2048 by 1536 pixels, 45° FOV, color fundus image — 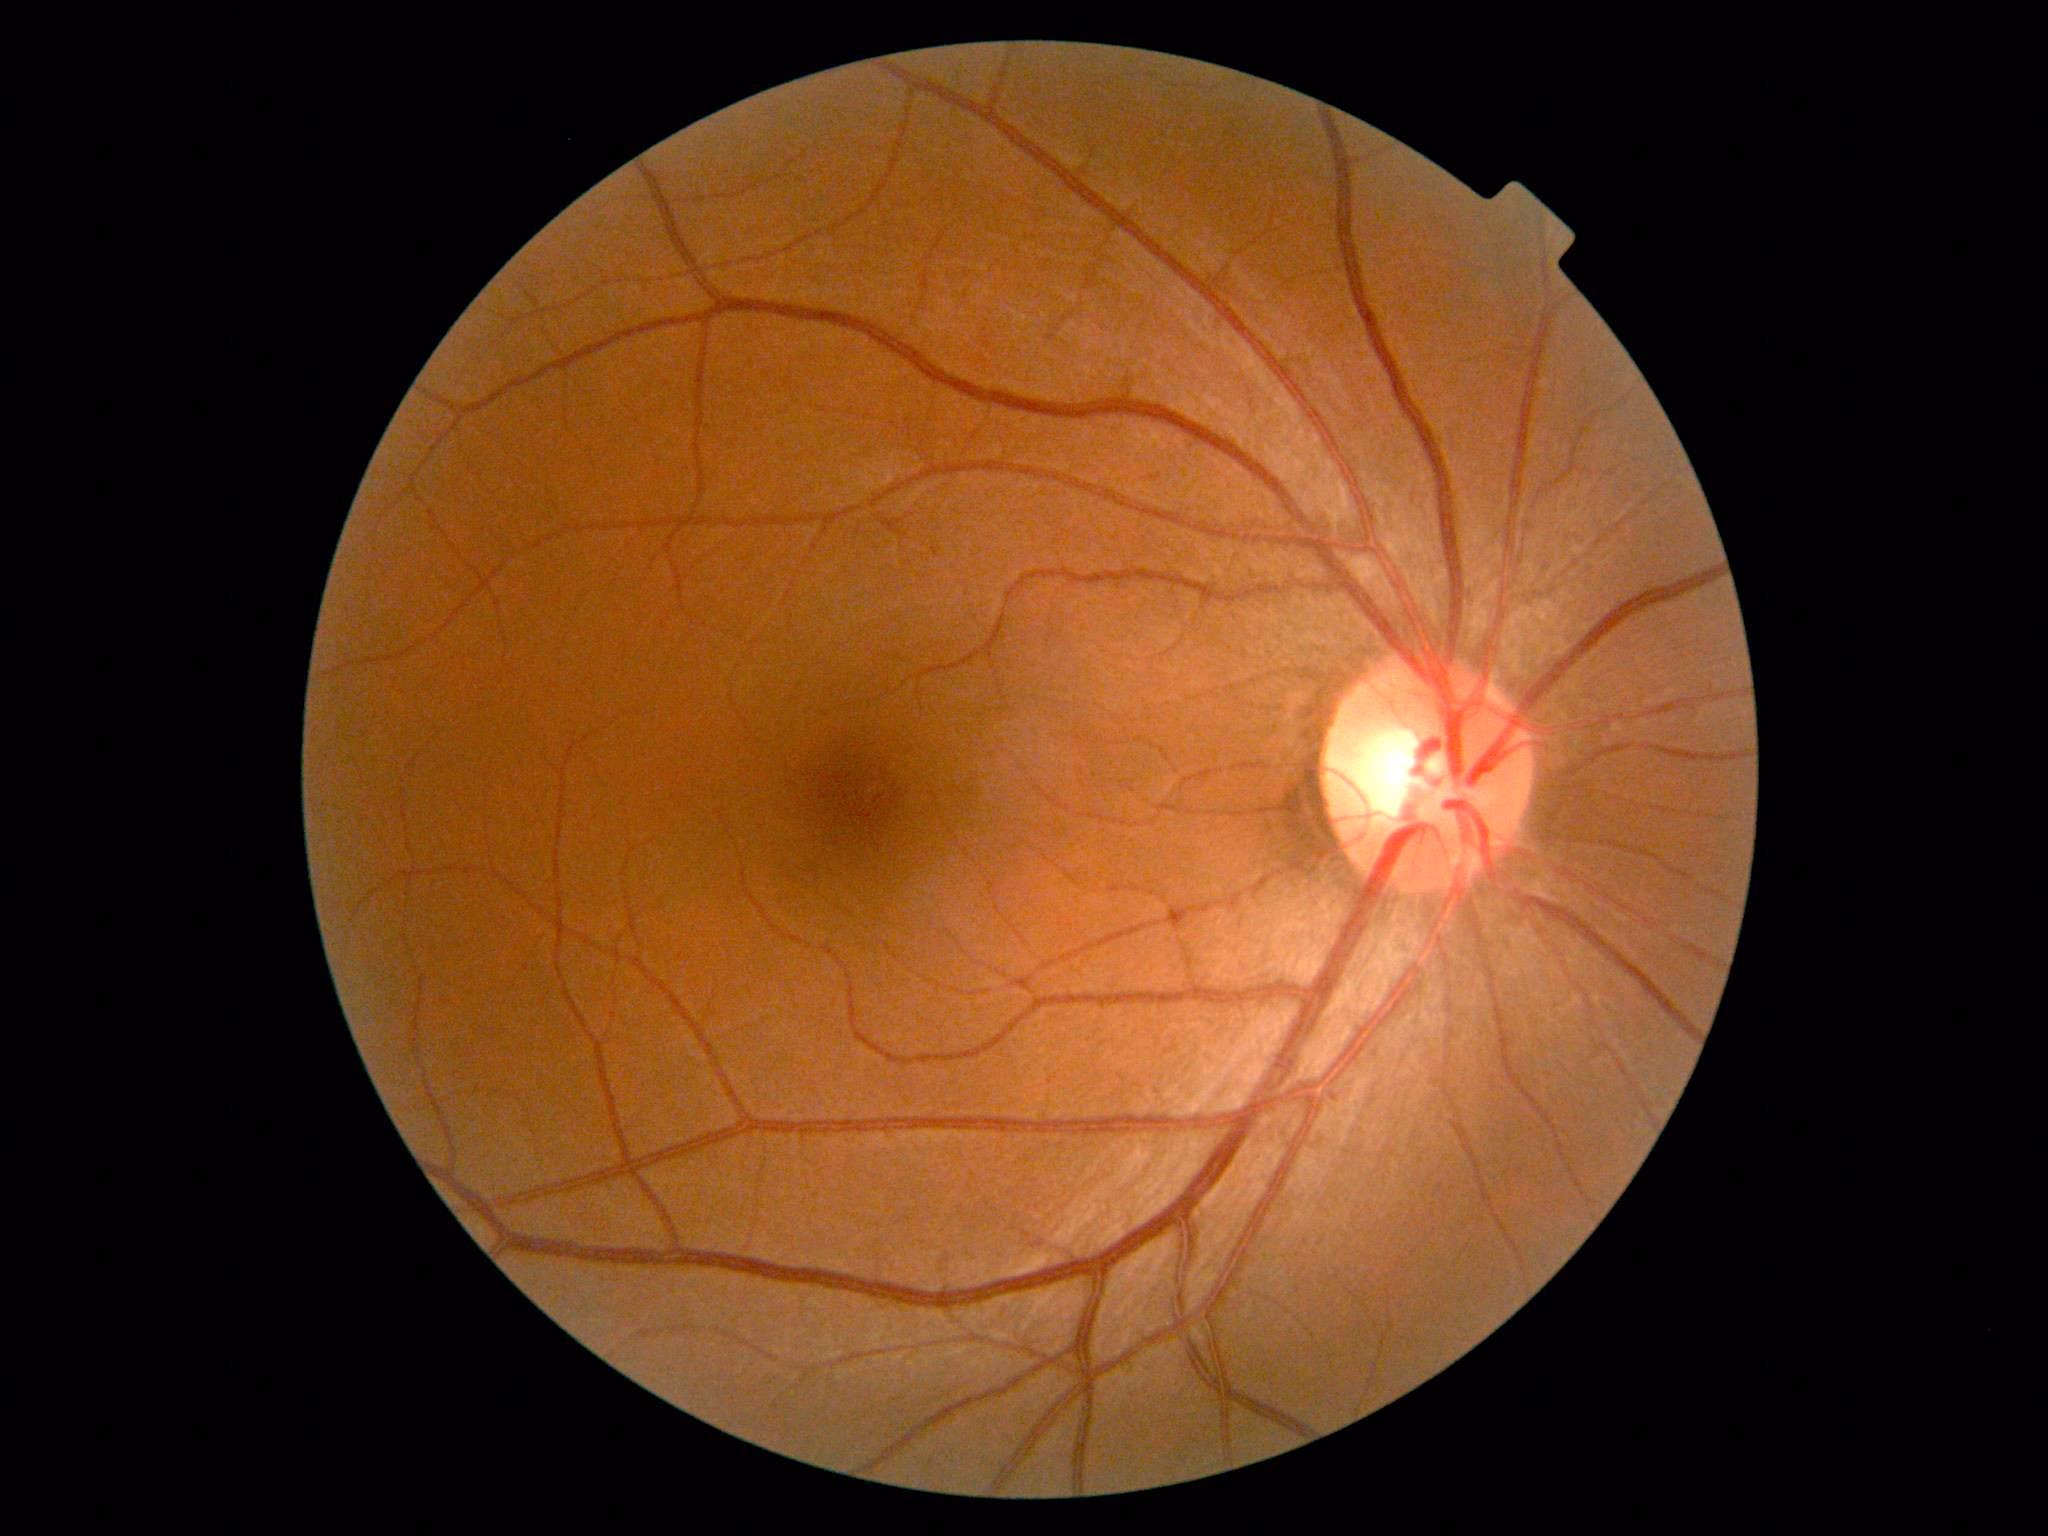
Diabetic retinopathy severity is no apparent diabetic retinopathy (grade 0) — no visible signs of diabetic retinopathy.